Infant wide-field fundus photograph; captured with the Phoenix ICON (100° field of view): 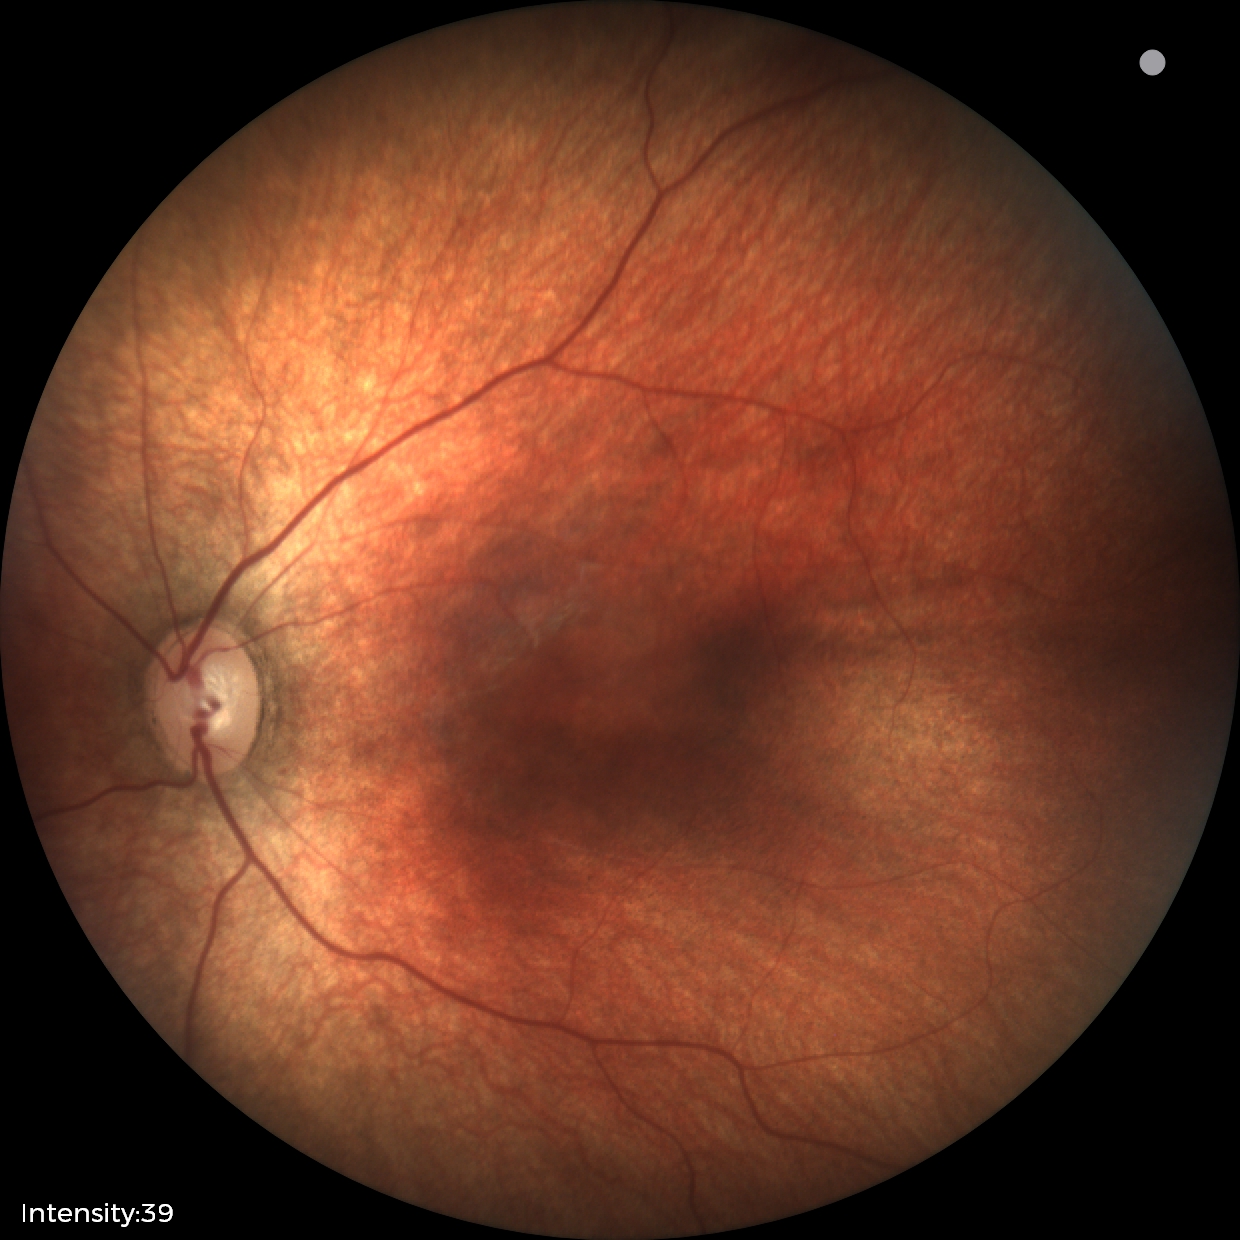

Impression: normal fundus examination.